1440 by 1080 pixels · pediatric retinal photograph (wide-field): 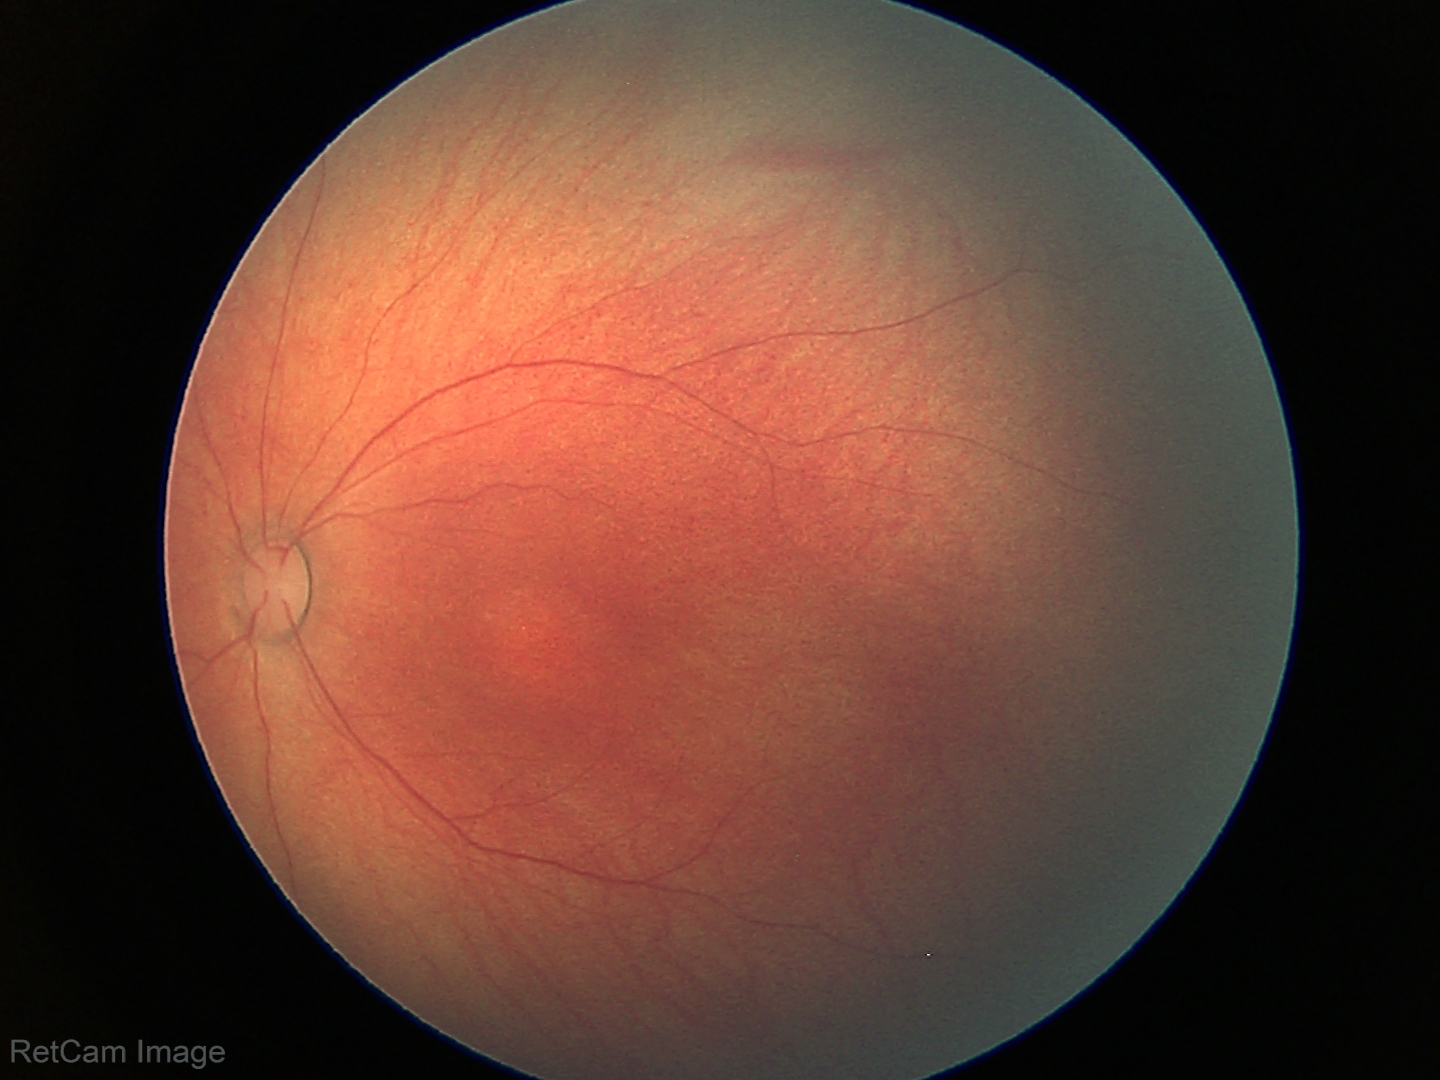
Screening examination with no abnormal retinal findings.